1444 by 1444 pixels:
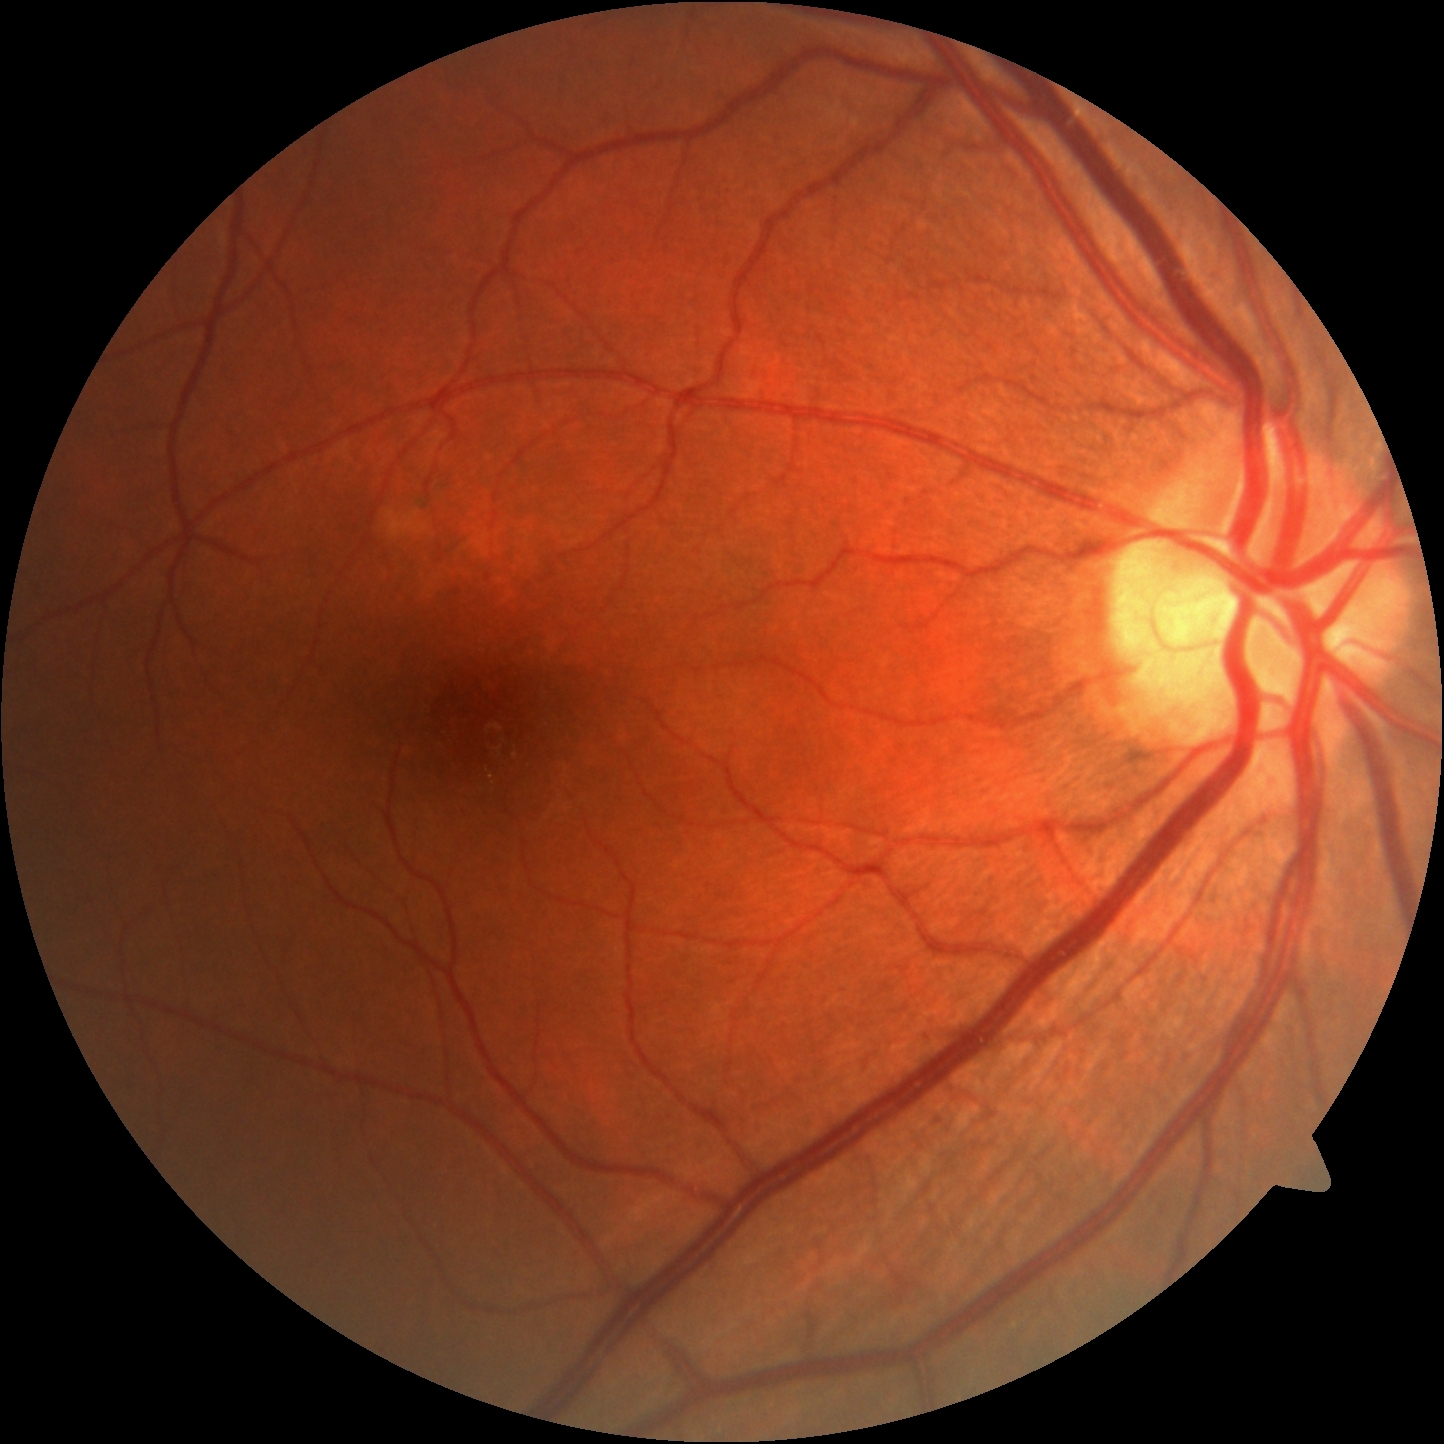 Findings:
– diabetic retinopathy — no apparent retinopathy (grade 0) — no visible signs of diabetic retinopathy
– DR impression — no apparent DR